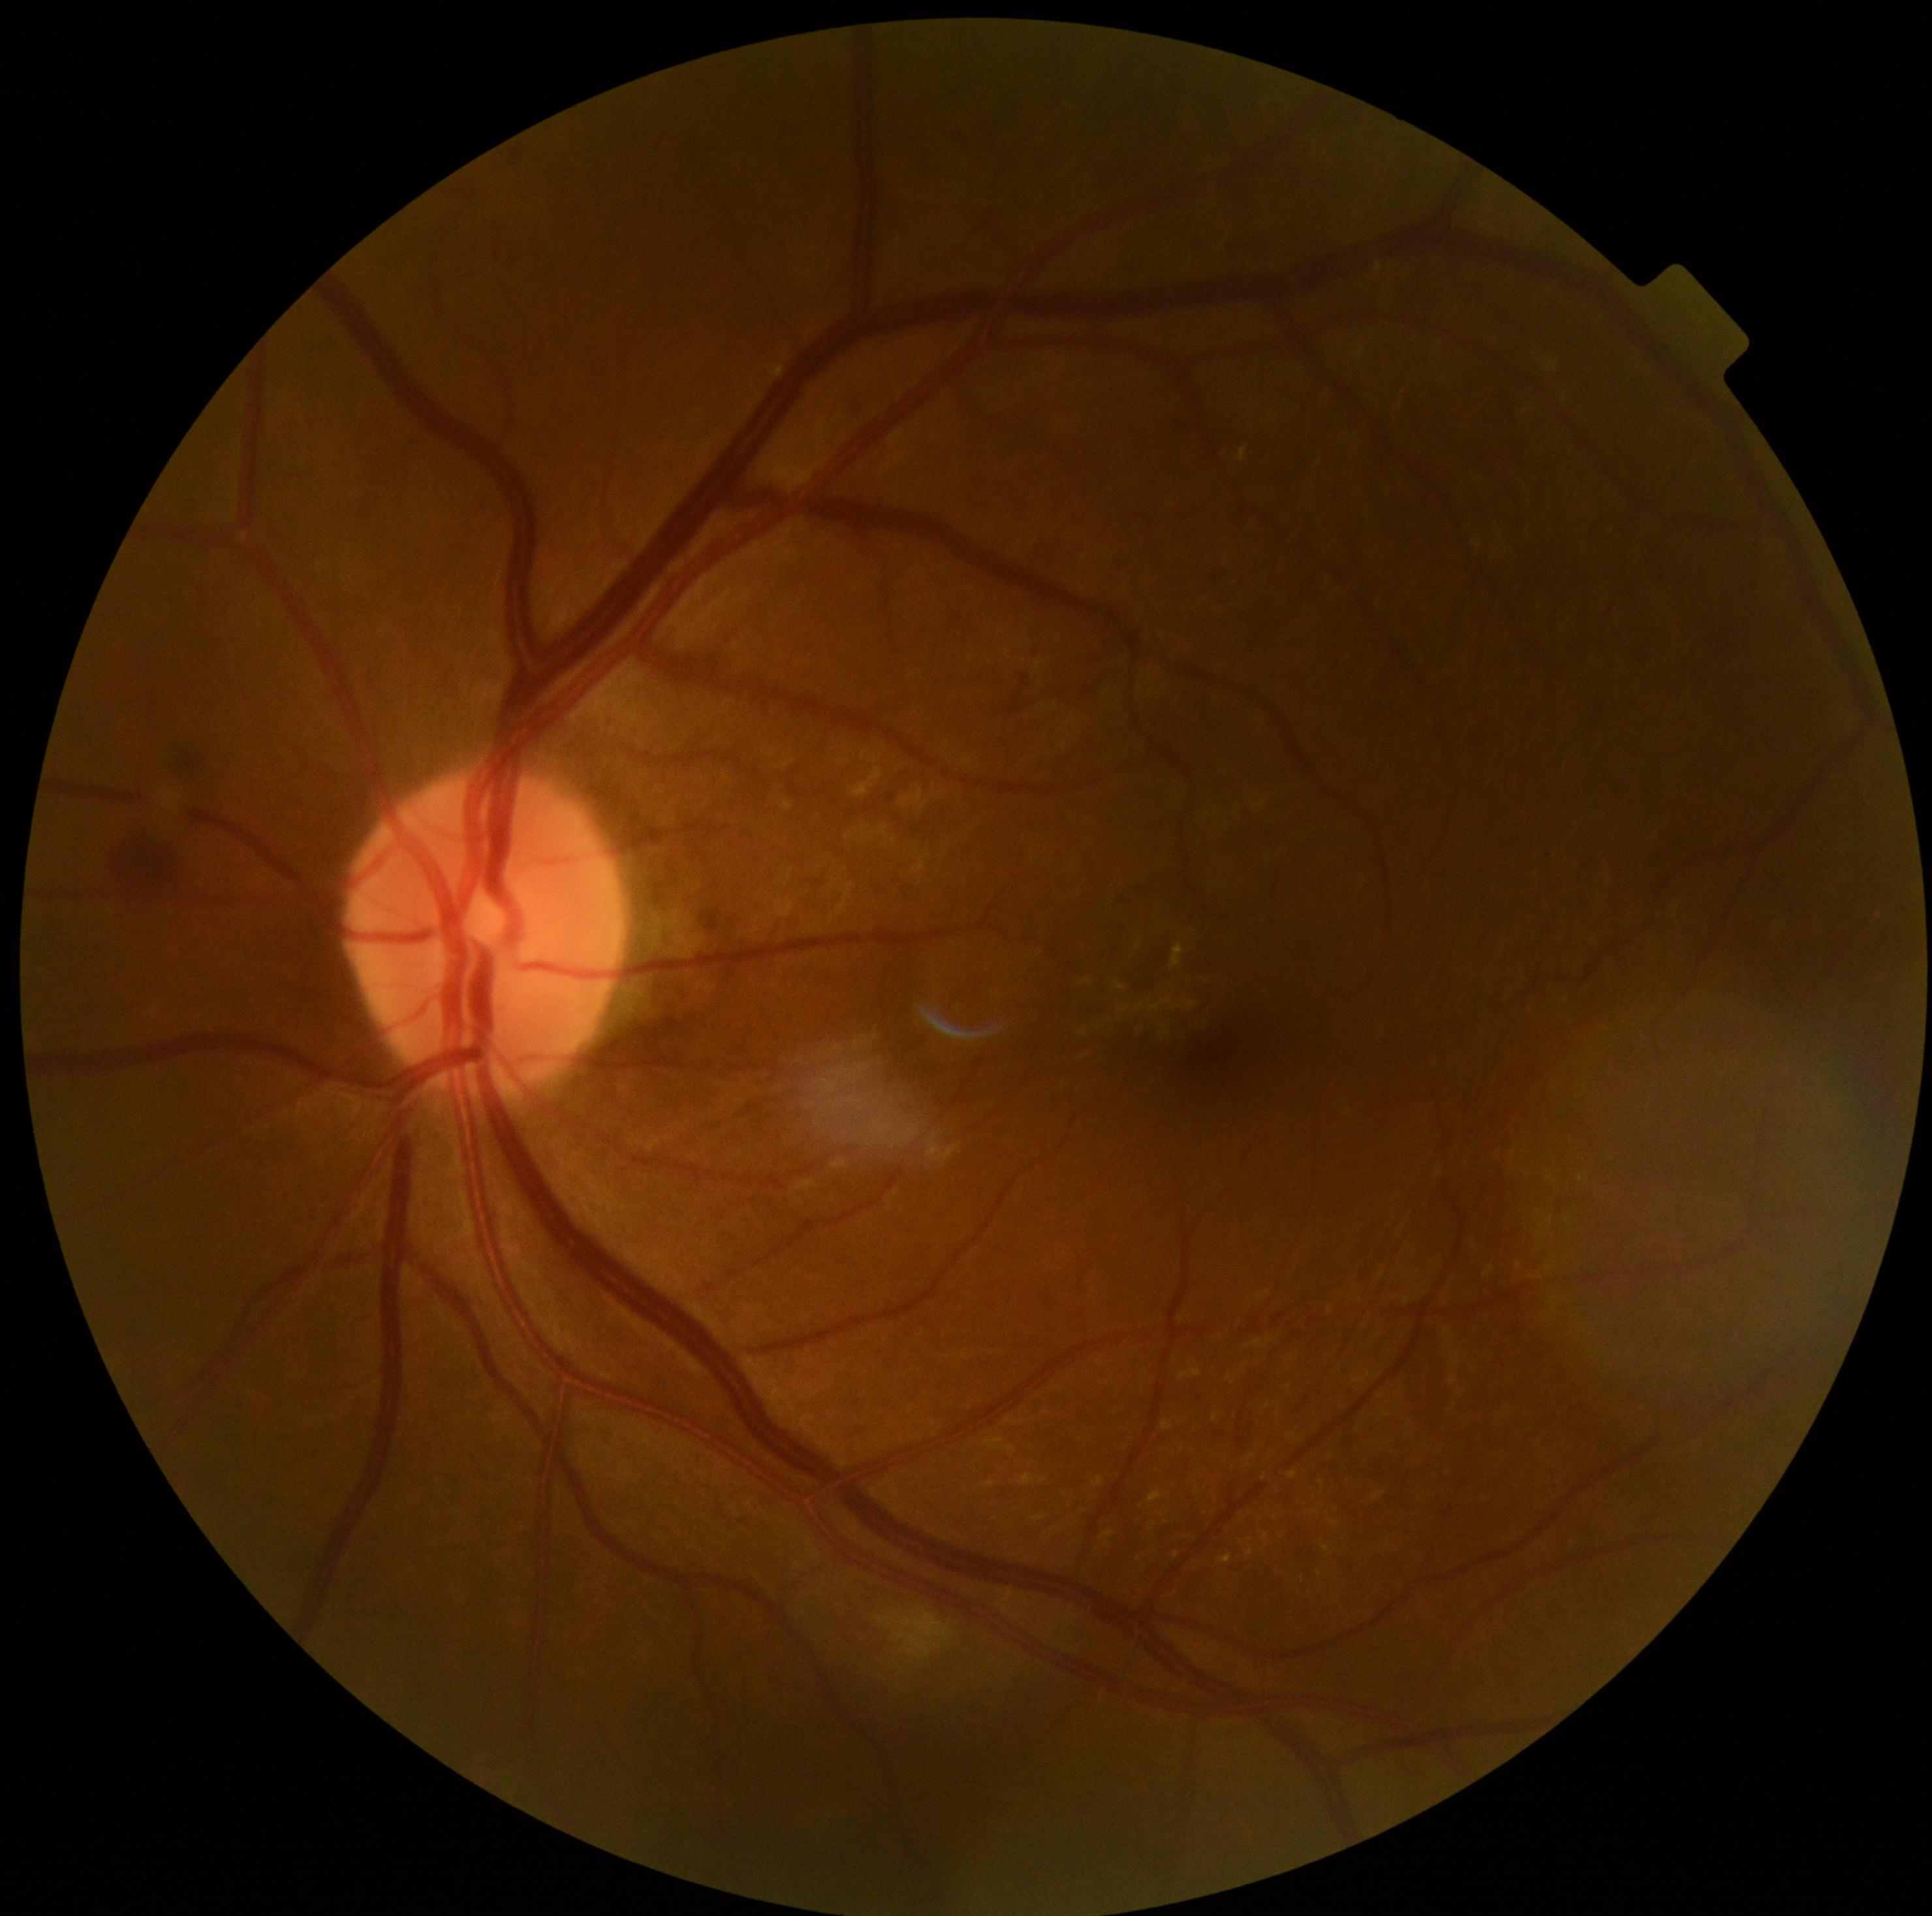 diabetic retinopathy severity = moderate non-proliferative diabetic retinopathy (grade 2).